2352 x 1568 pixels — 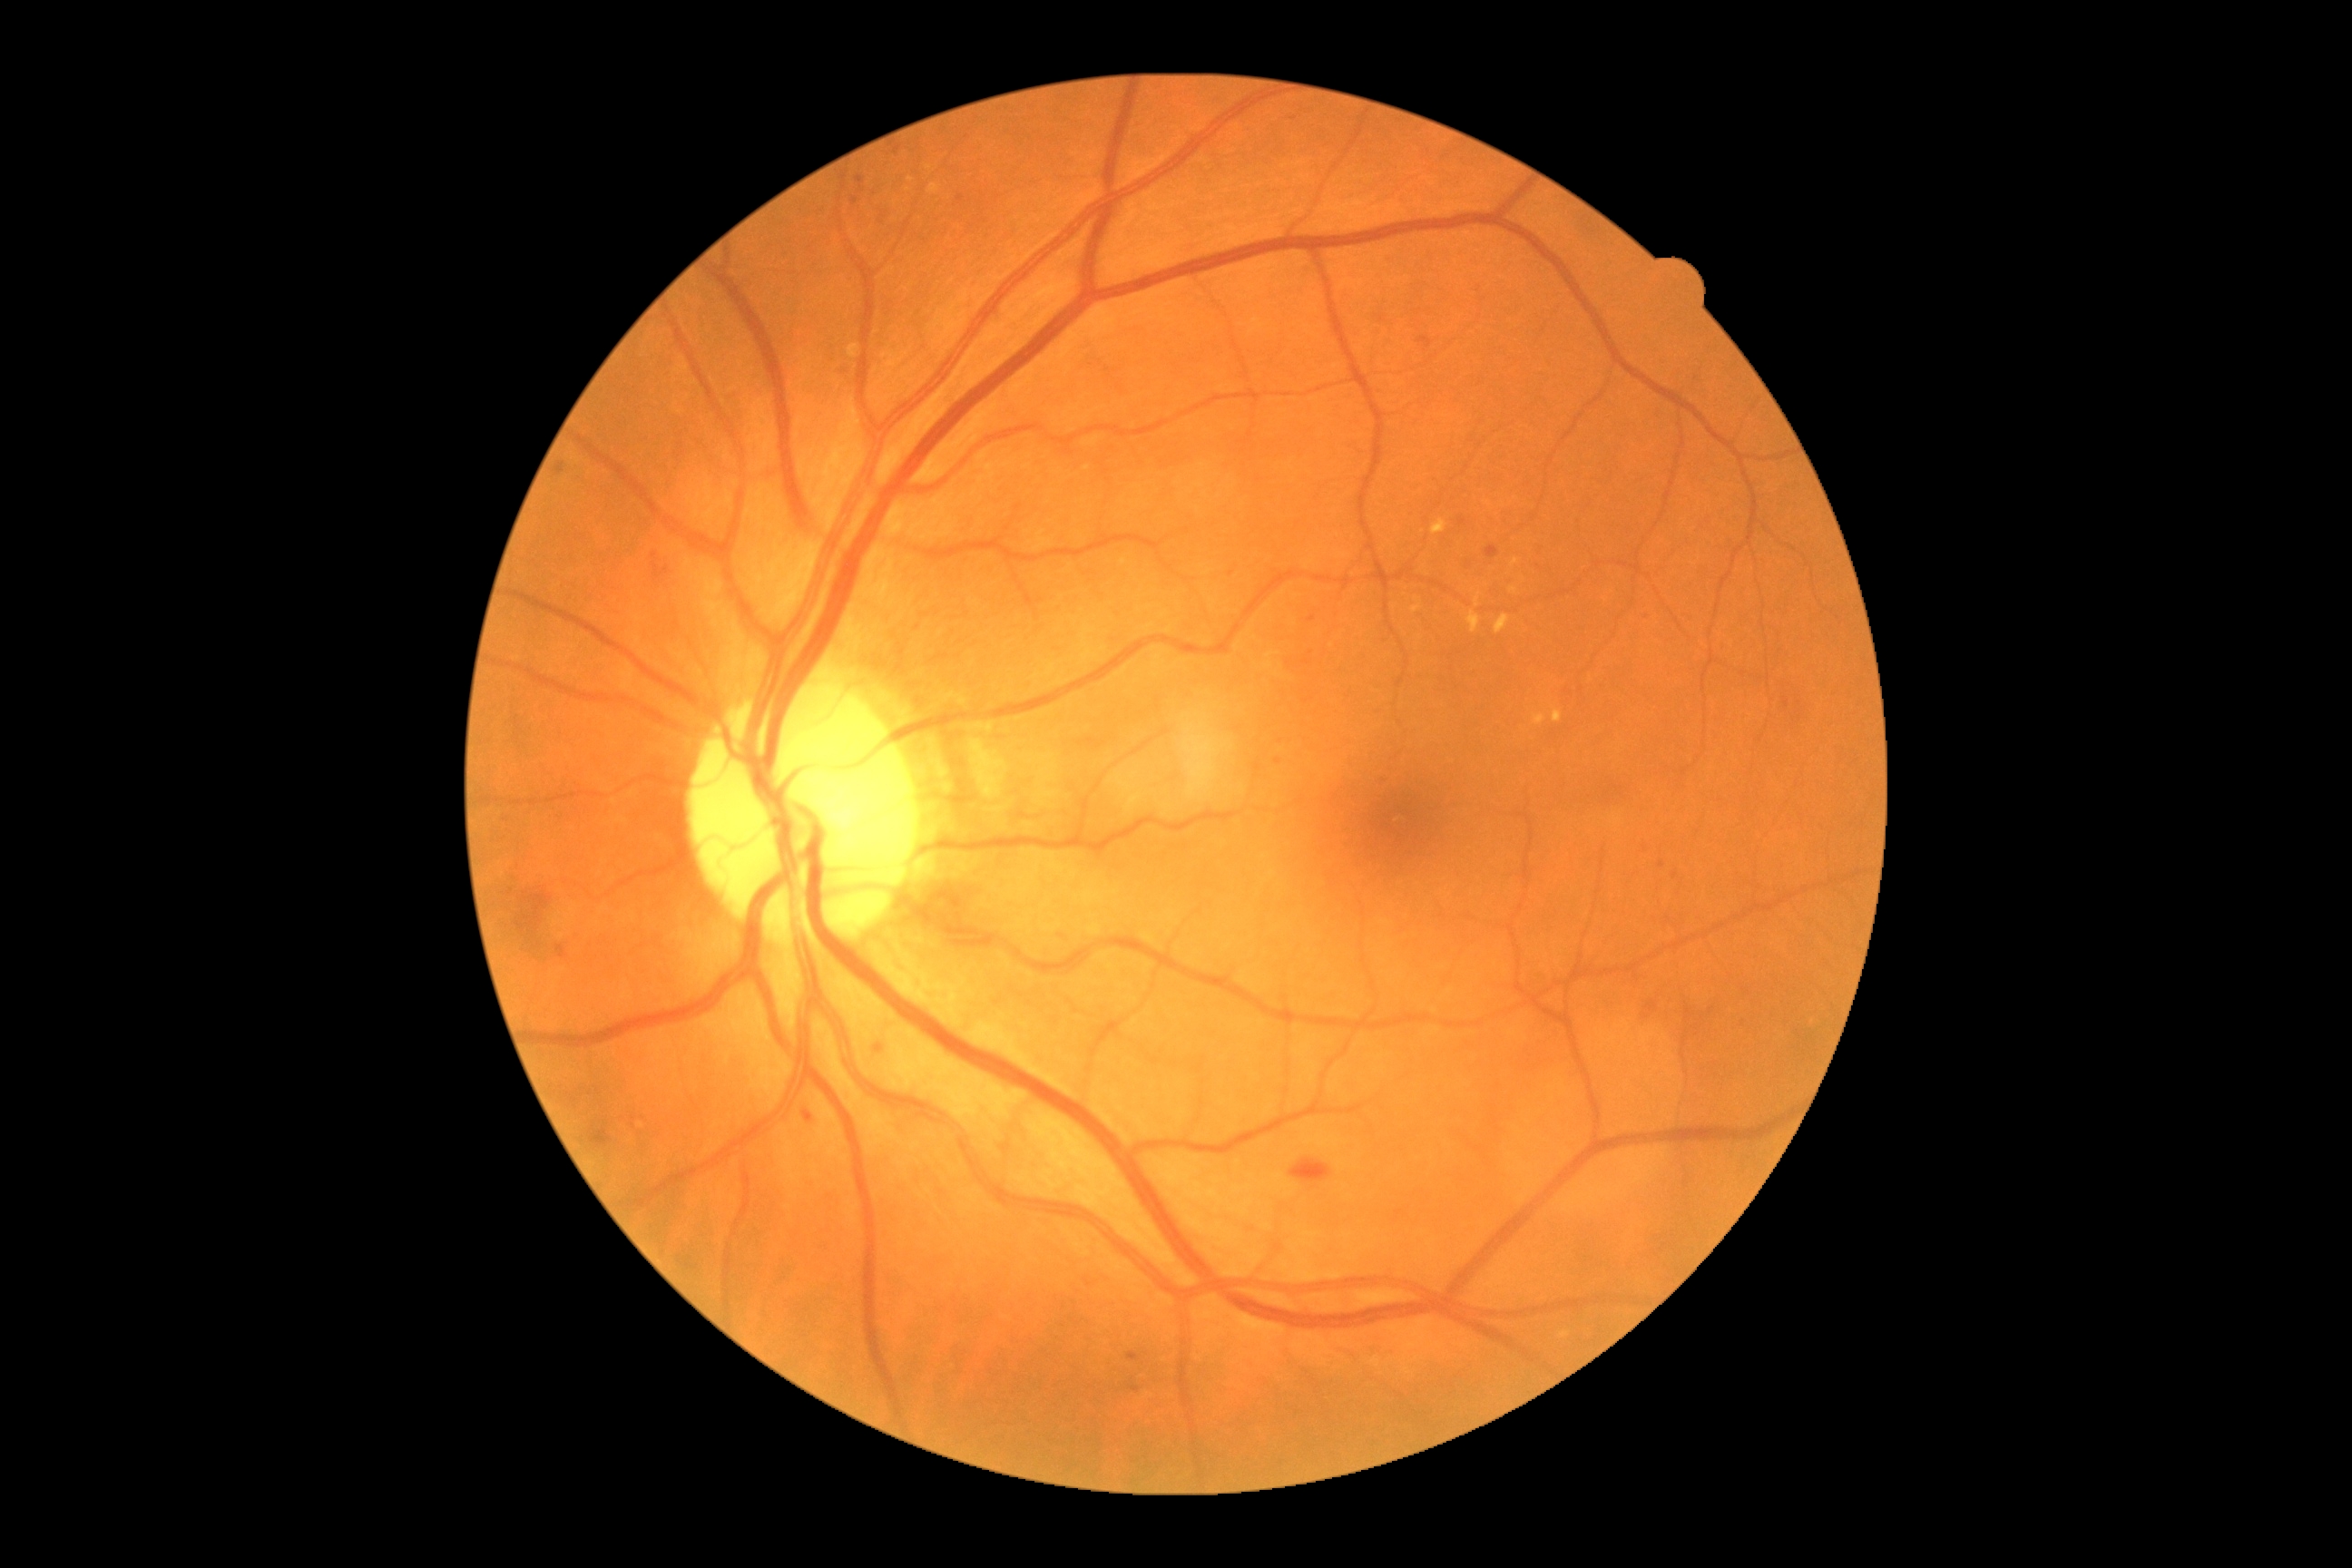

DR: moderate NPDR (grade 2)
Selected lesions:
MAs (subset): {"left": 1378, "top": 776, "right": 1382, "bottom": 787}; {"left": 1785, "top": 698, "right": 1790, "bottom": 709}; {"left": 894, "top": 146, "right": 901, "bottom": 155}; {"left": 556, "top": 464, "right": 565, "bottom": 476}; {"left": 1418, "top": 337, "right": 1433, "bottom": 348}; {"left": 1643, "top": 611, "right": 1652, "bottom": 622}; {"left": 852, "top": 197, "right": 859, "bottom": 206}
Smaller MAs around pt(1306, 662); pt(1311, 619); pt(1647, 848); pt(960, 199)